Modified Davis classification:
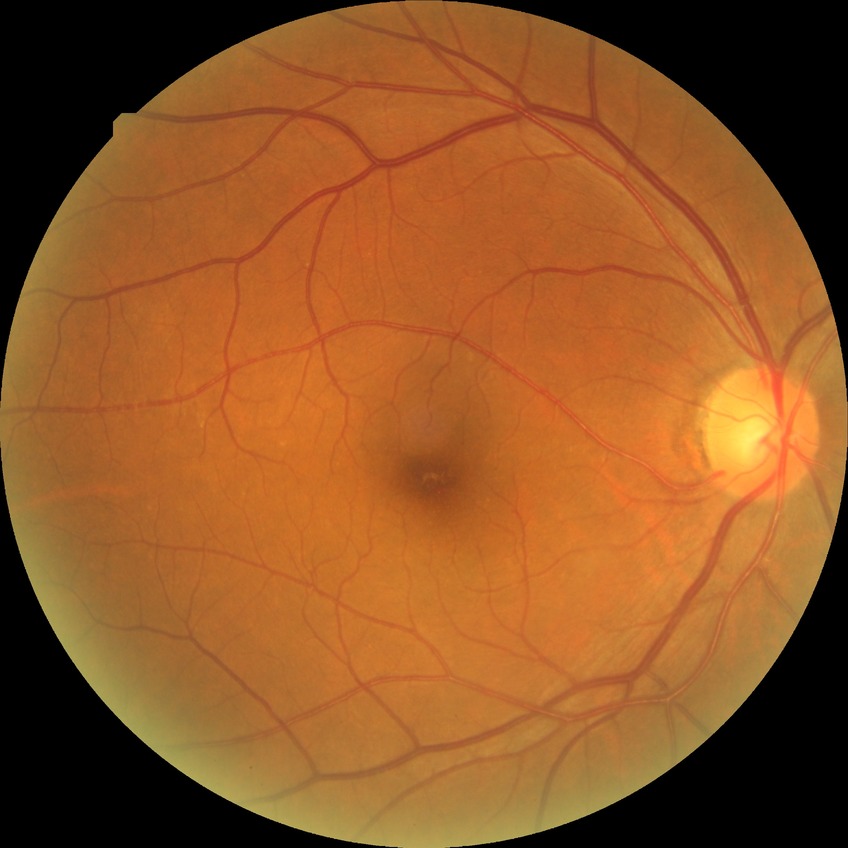 Findings:
– Davis DR grade: NDR
– DR impression: no DR findings